45-degree field of view — 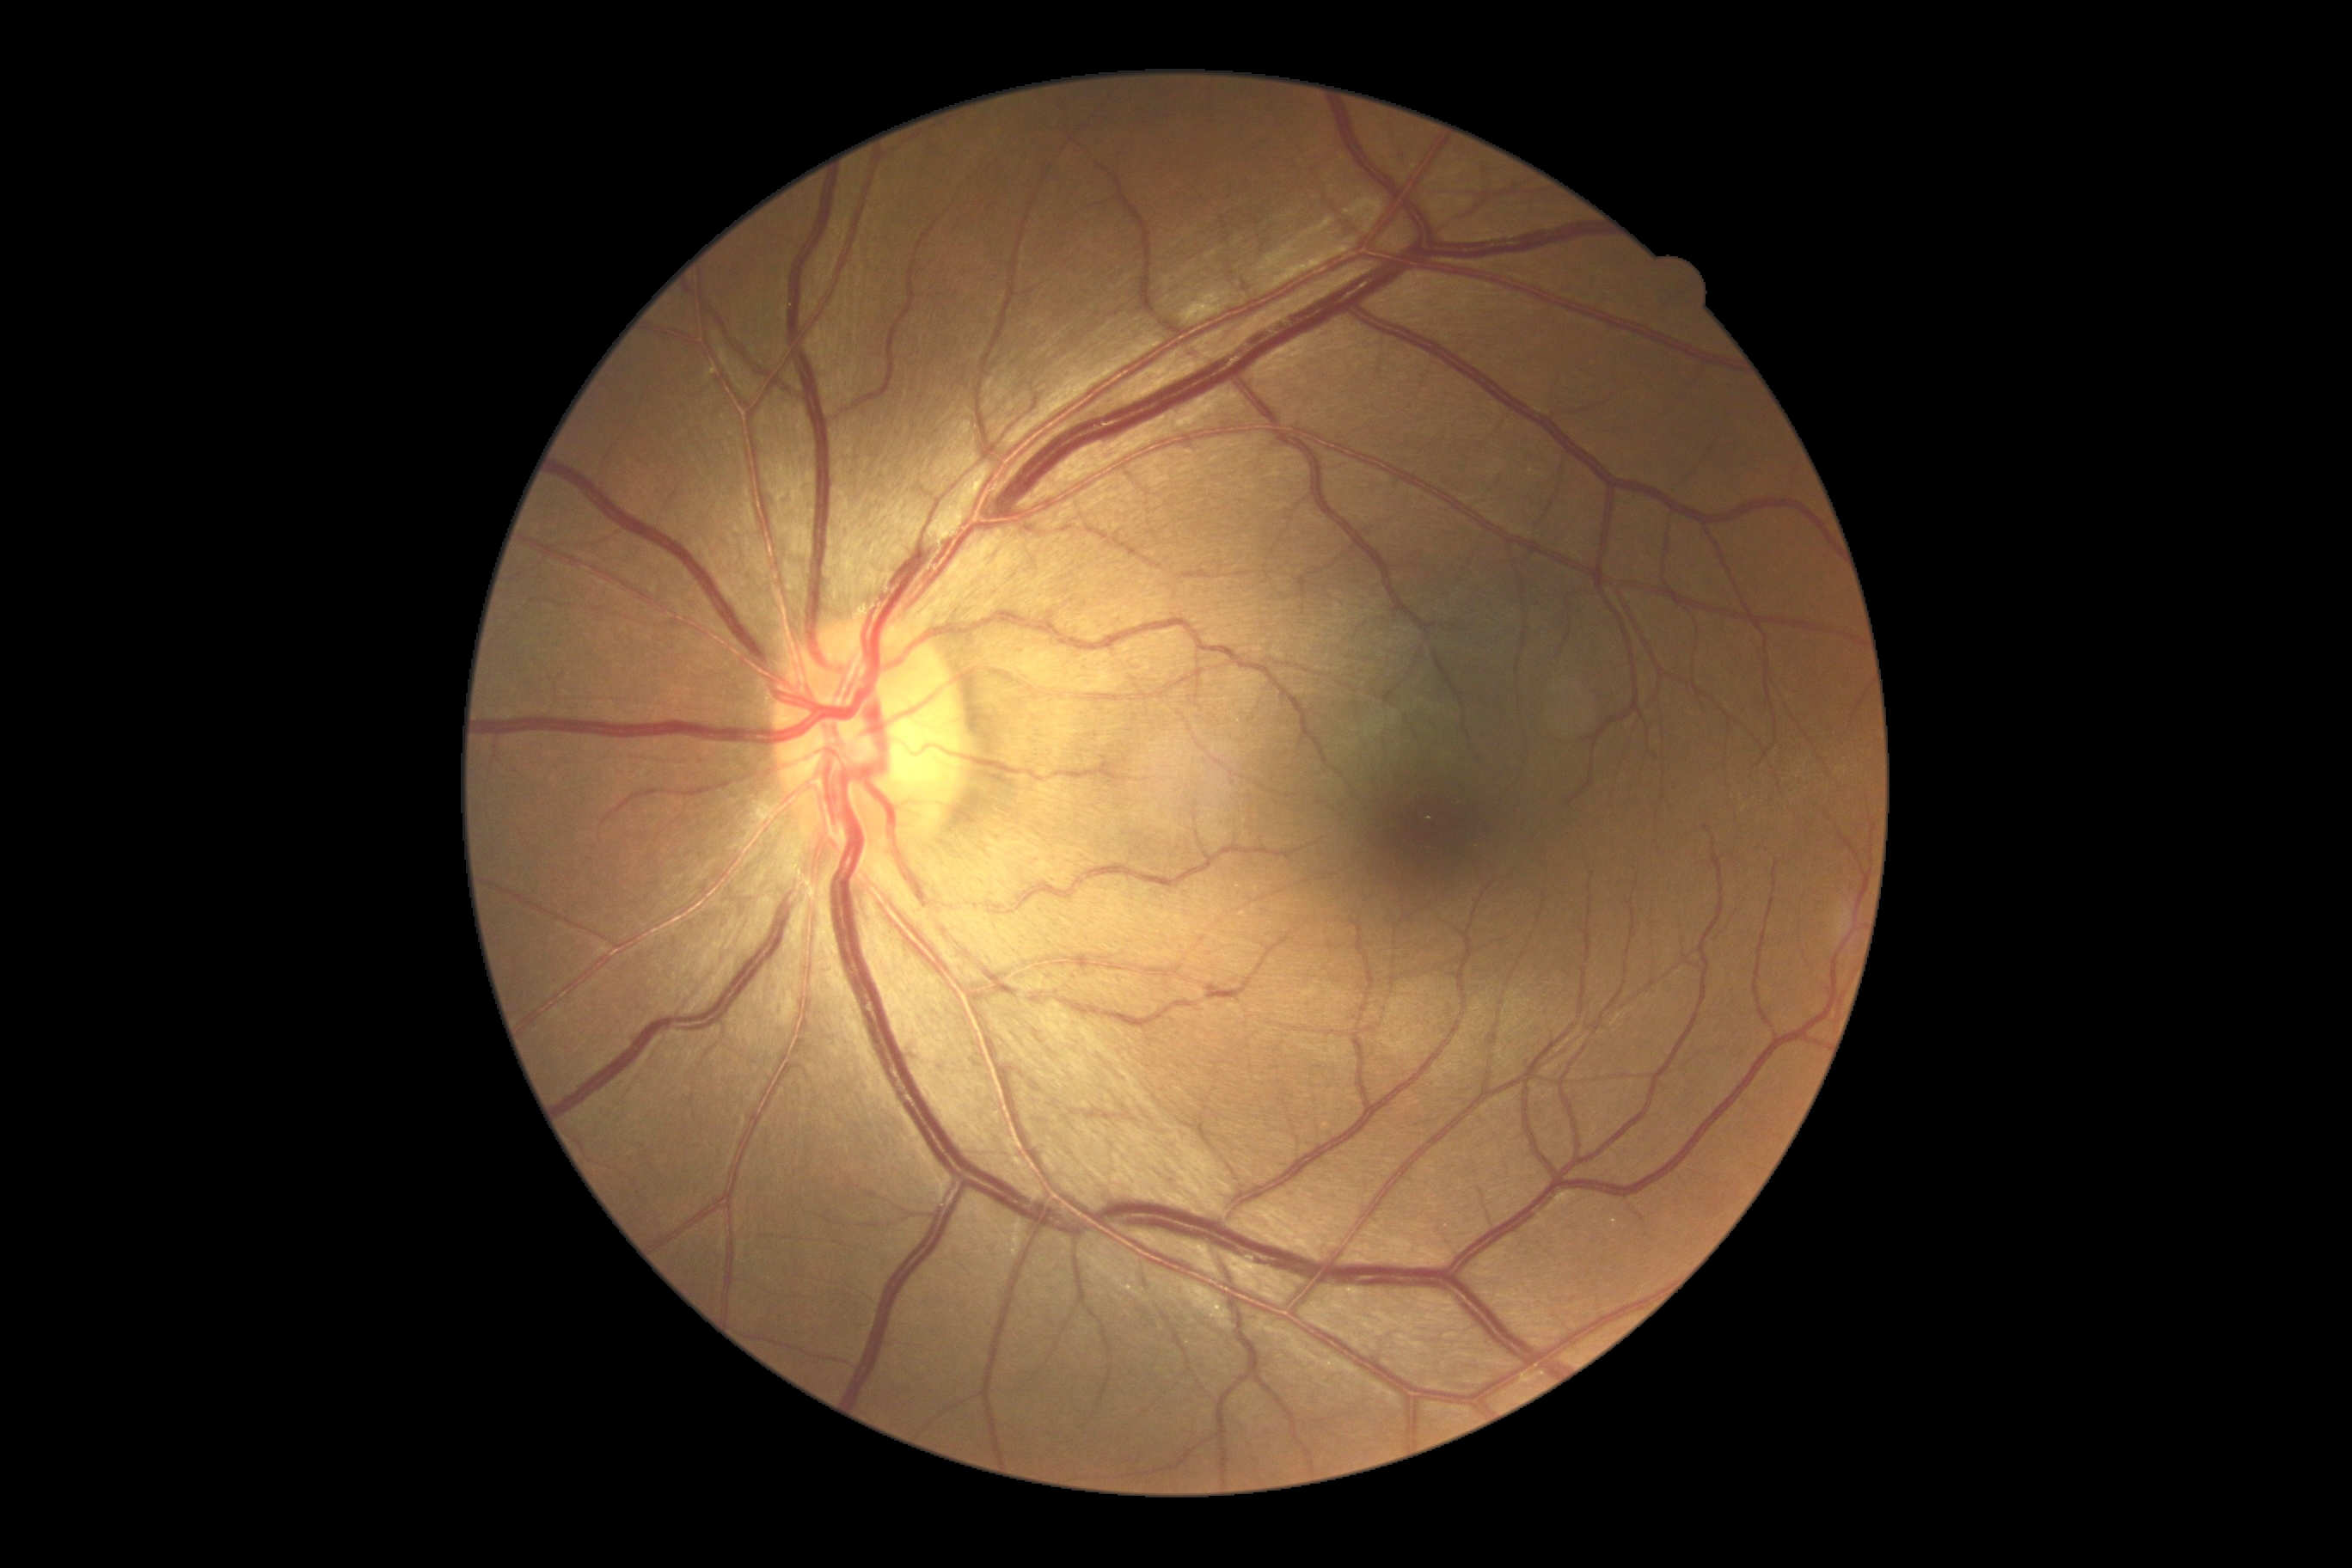
retinopathy: no apparent diabetic retinopathy (grade 0).